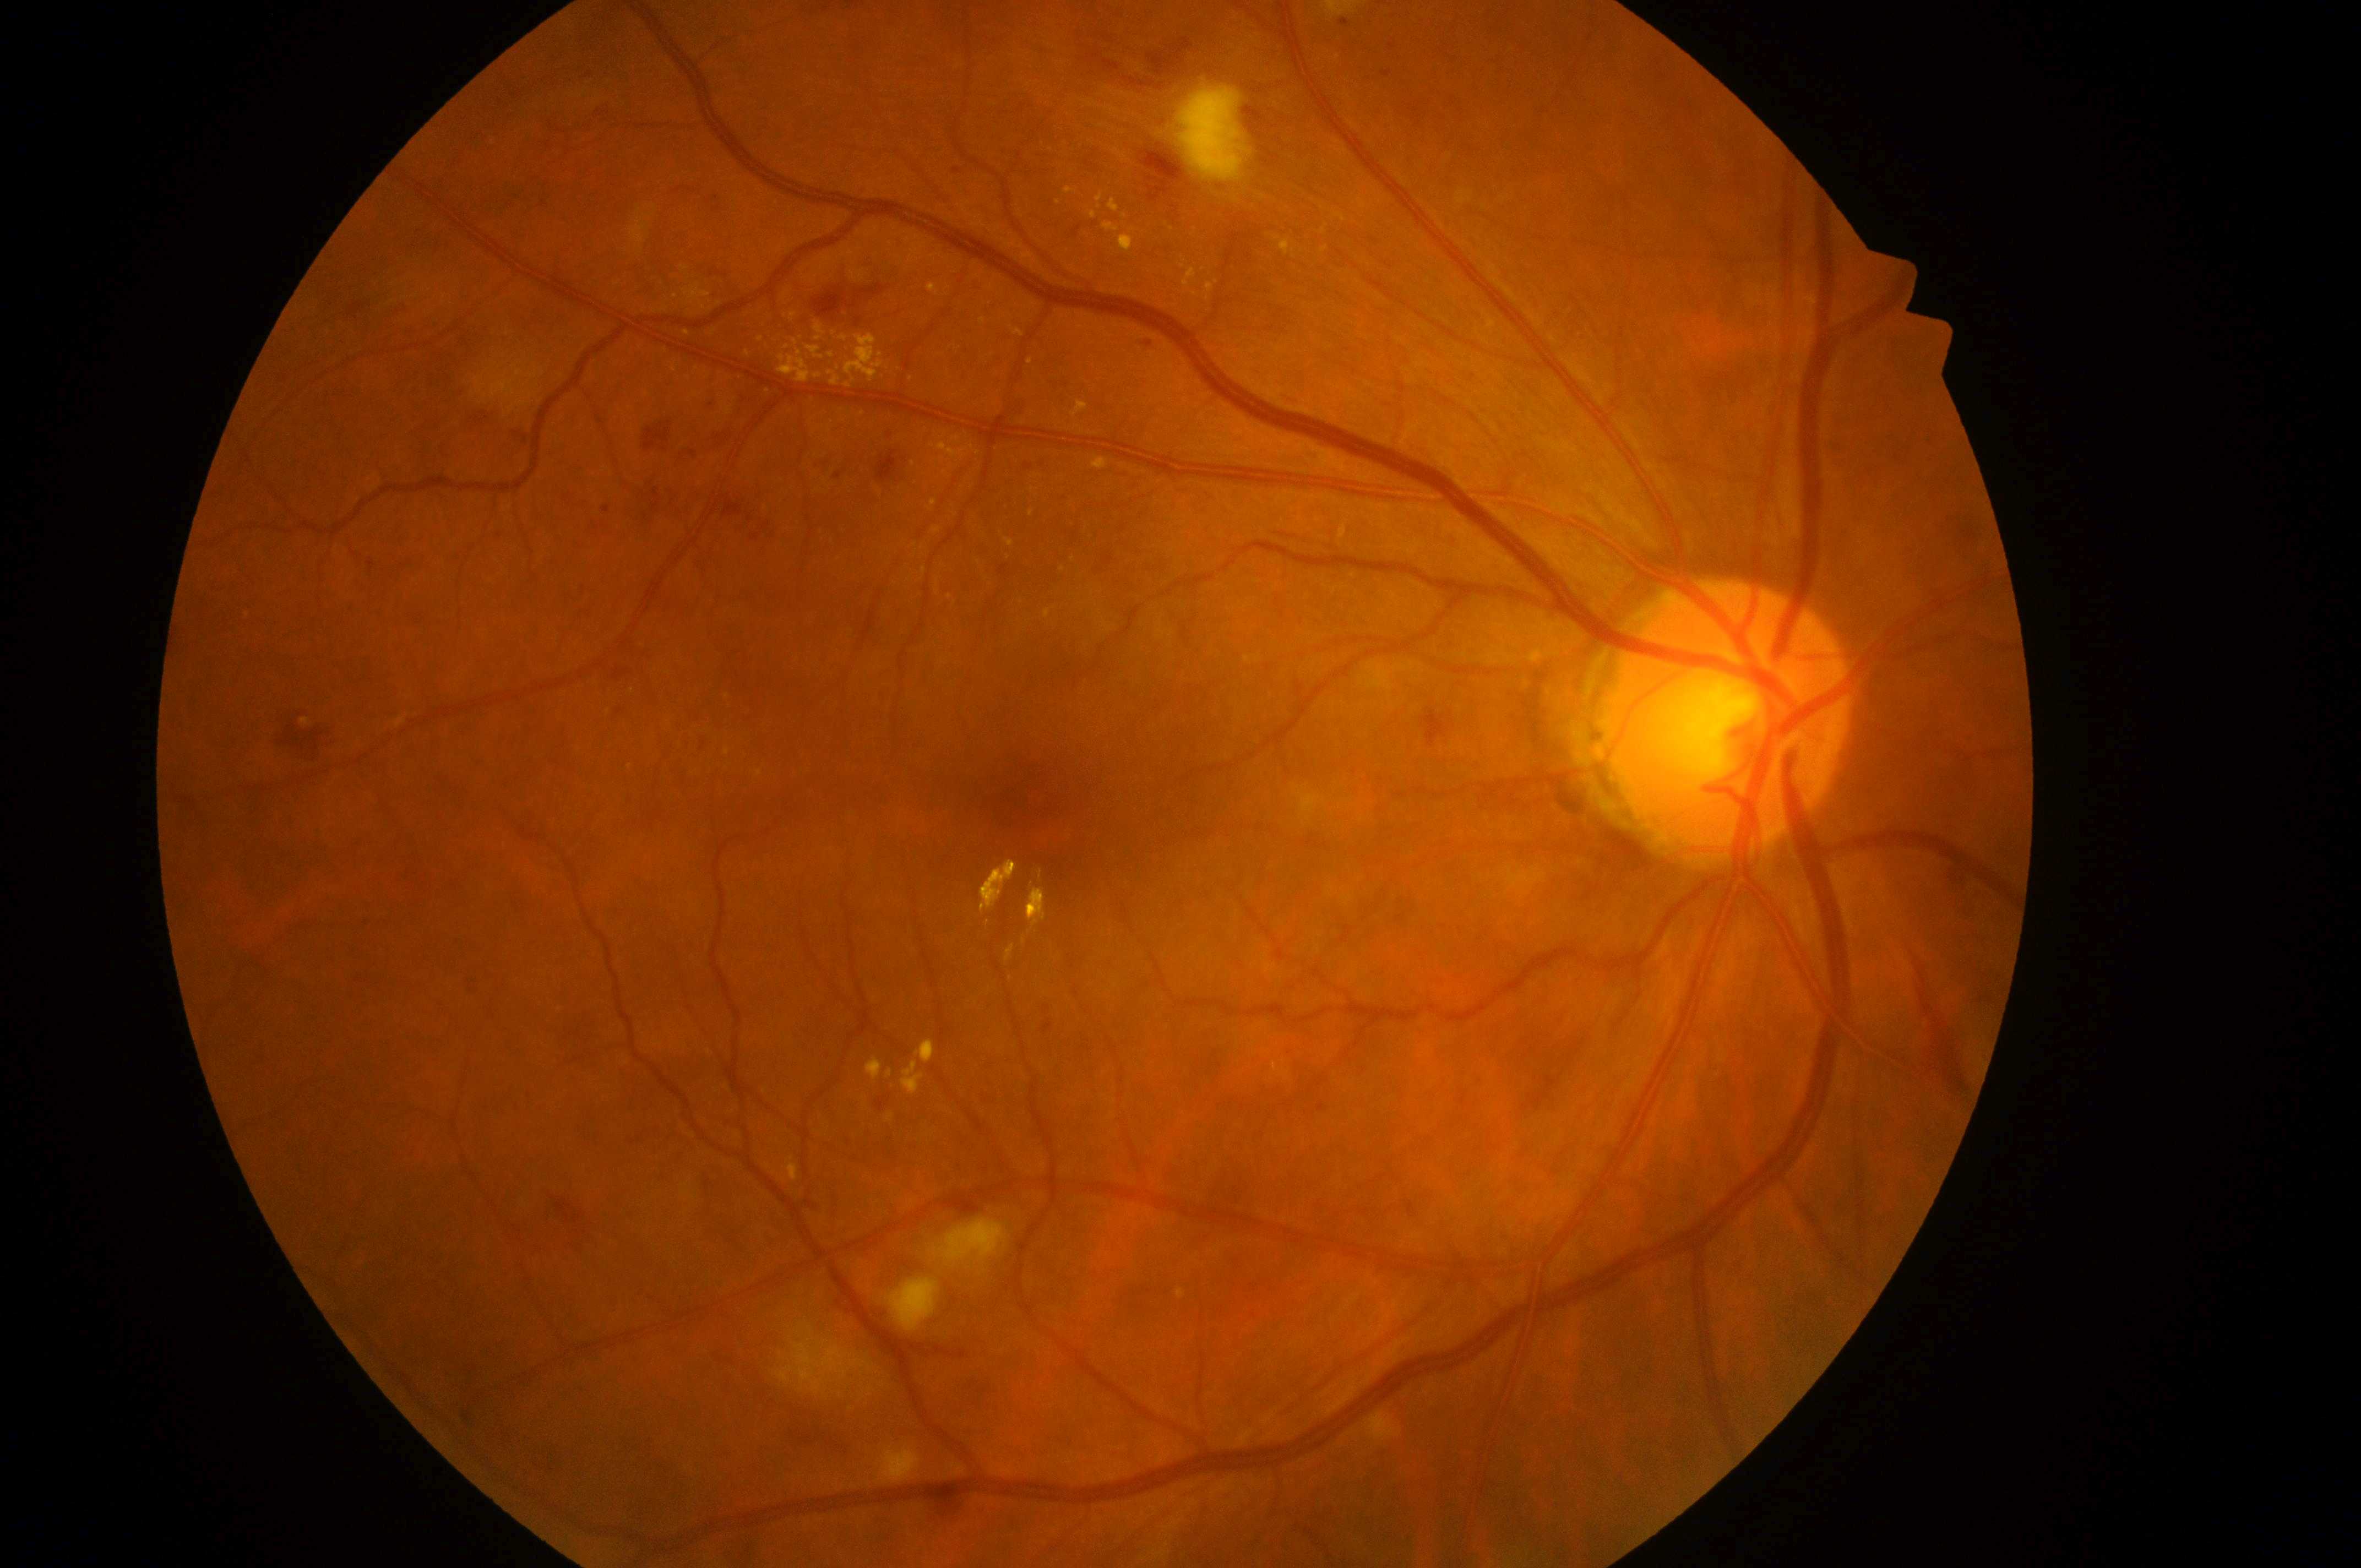 {"dr_grade": "moderate NPDR (grade 2)", "optic_disc": "(1720,726)", "fovea": "(1046,814)", "dme_grade": "2 (high risk)", "eye": "right eye"}